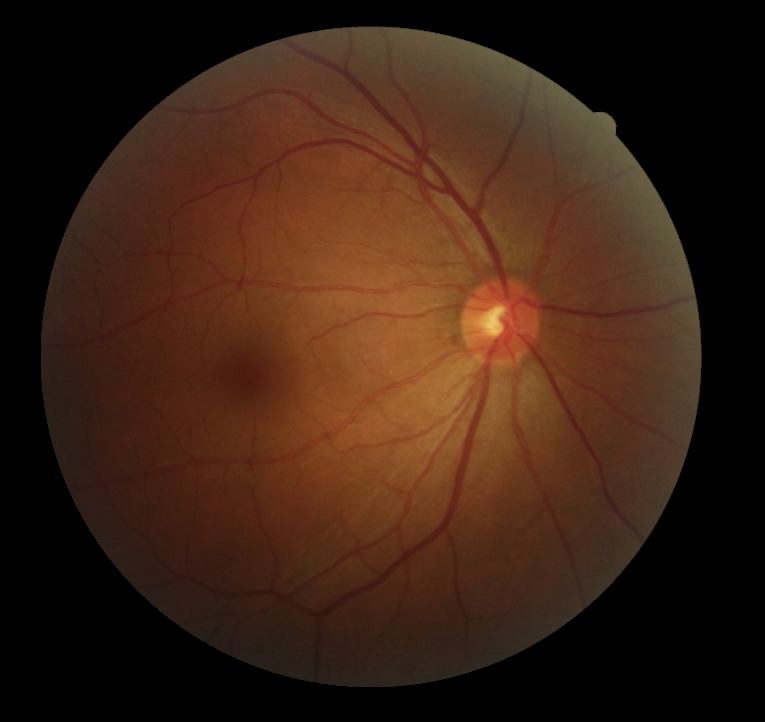

Retinopathy grade is 0 — no visible signs of diabetic retinopathy.